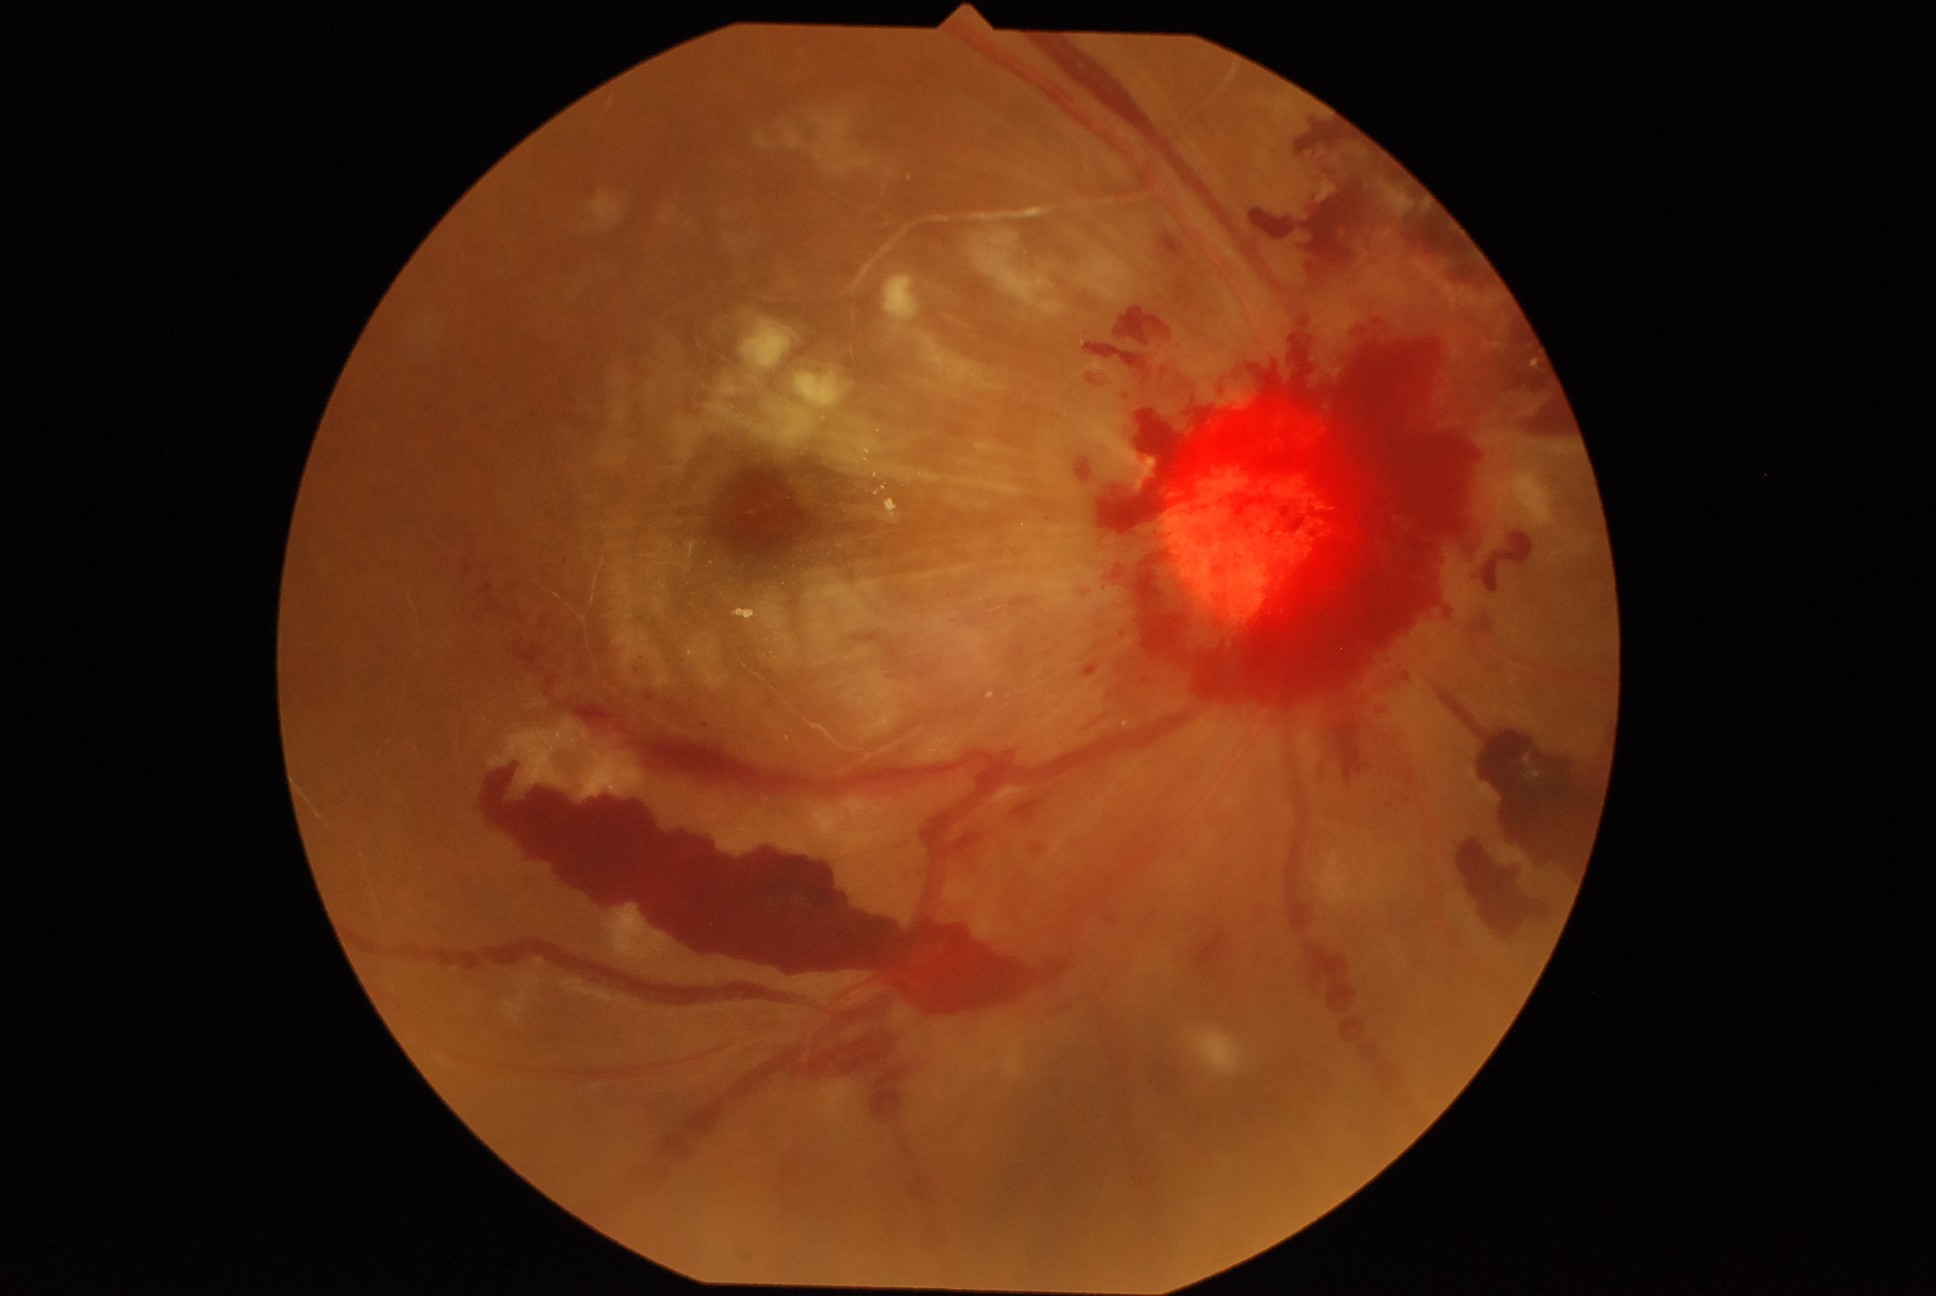
Annotations:
– diabetic retinopathy severity — 4 — neovascularization and/or vitreous/pre-retinal hemorrhage